Color fundus photograph, 848 by 848 pixels, NIDEK AFC-230:
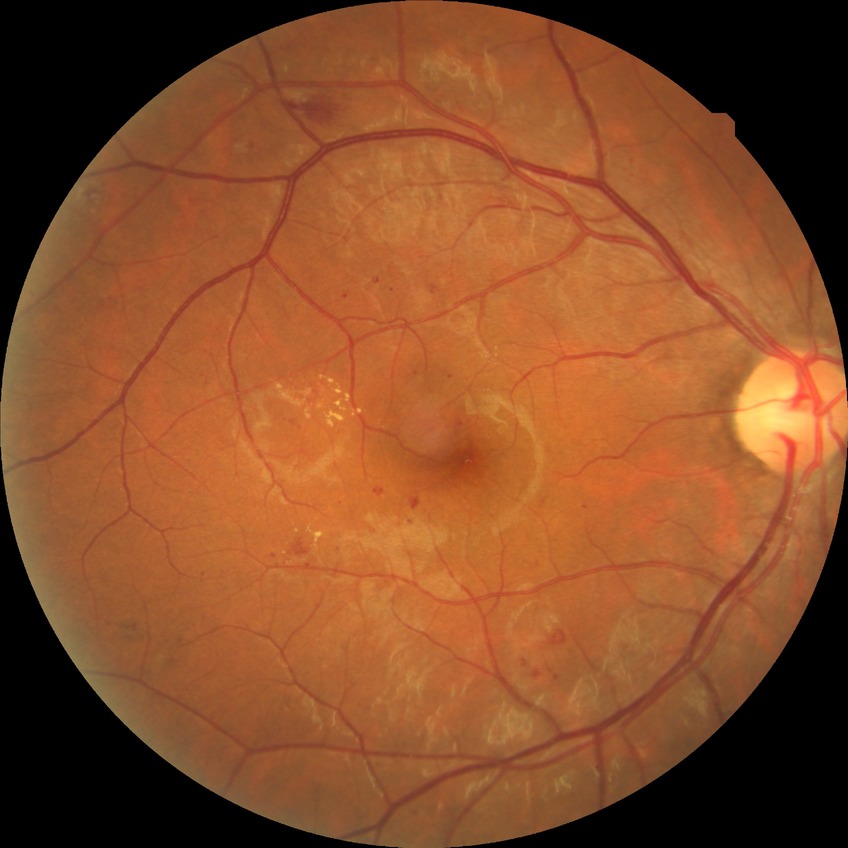 {
  "davis_grade": "simple diabetic retinopathy (SDR)"
}